Retinal fundus photograph — 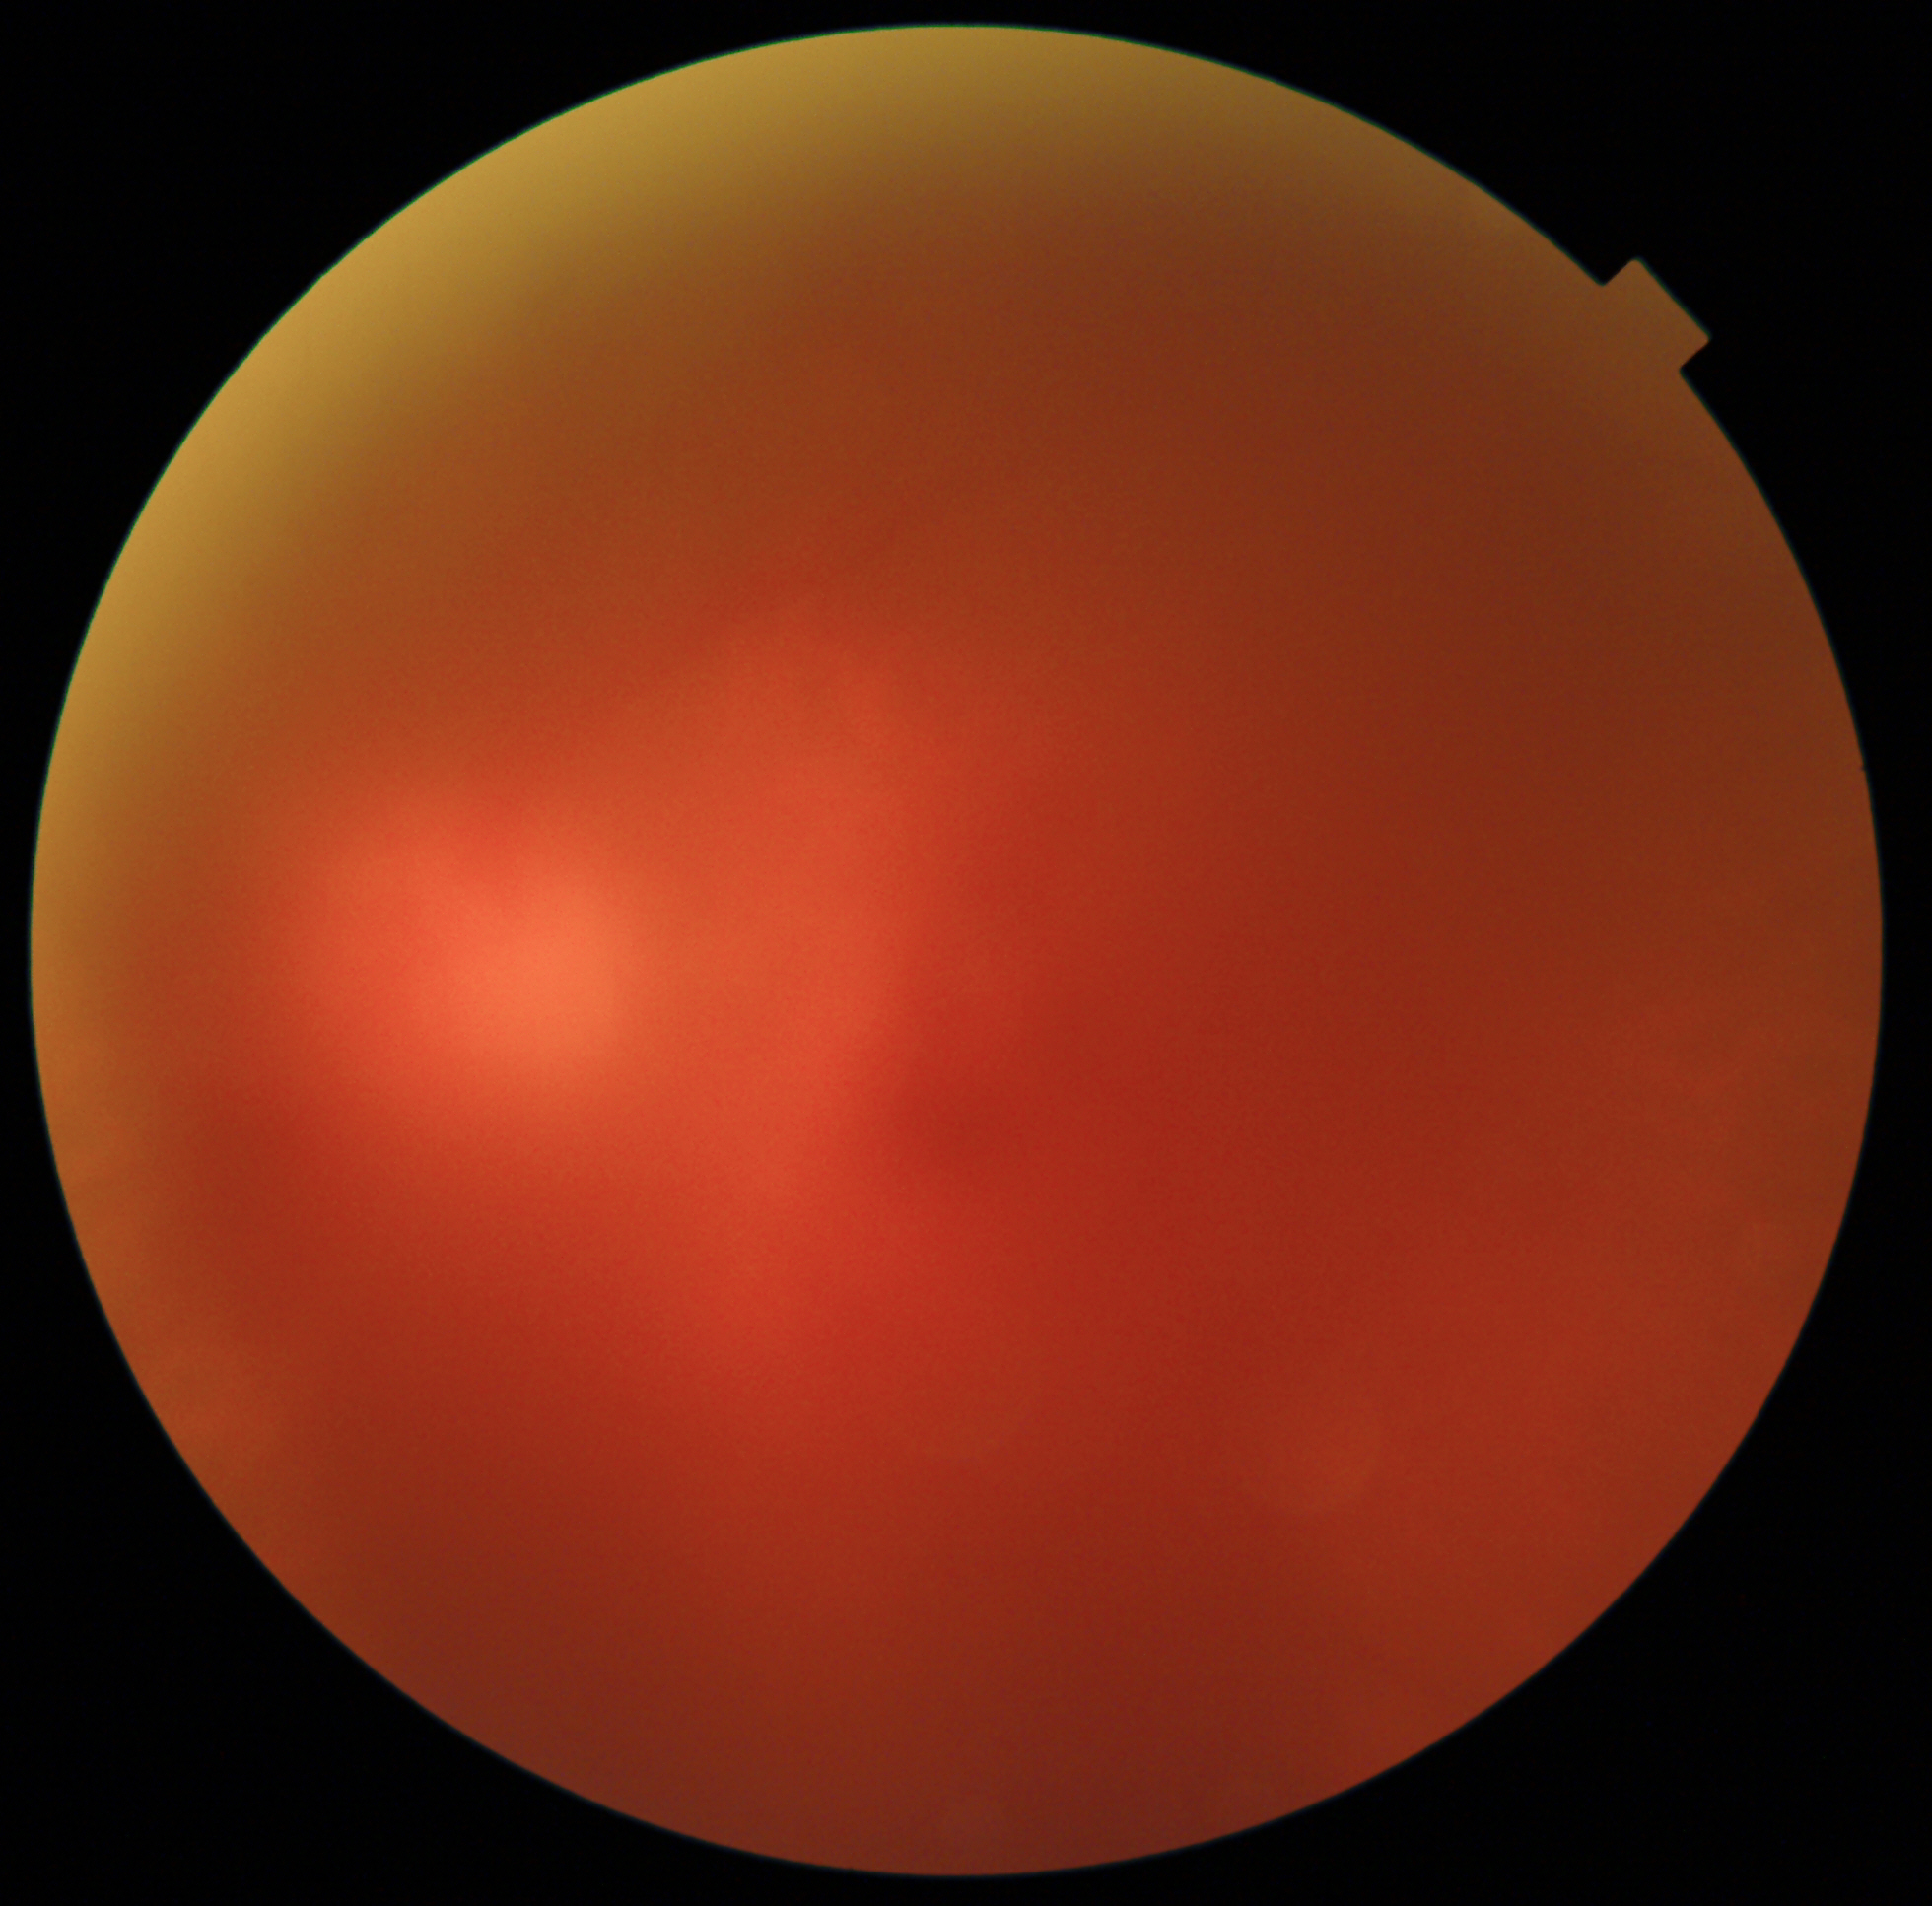
Image quality is poor; more than half the field is obscured. No evidence of proliferative diabetic retinopathy.